Image size 848x848: 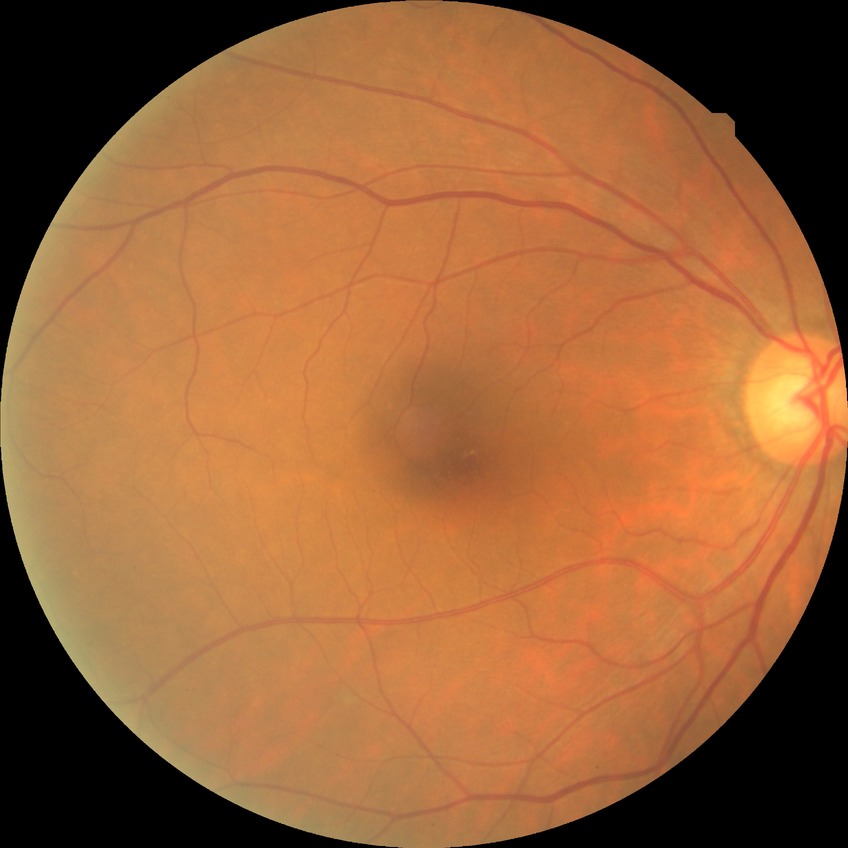
diabetic retinopathy (DR): NDR (no diabetic retinopathy).